Wide-field fundus photograph of an infant: 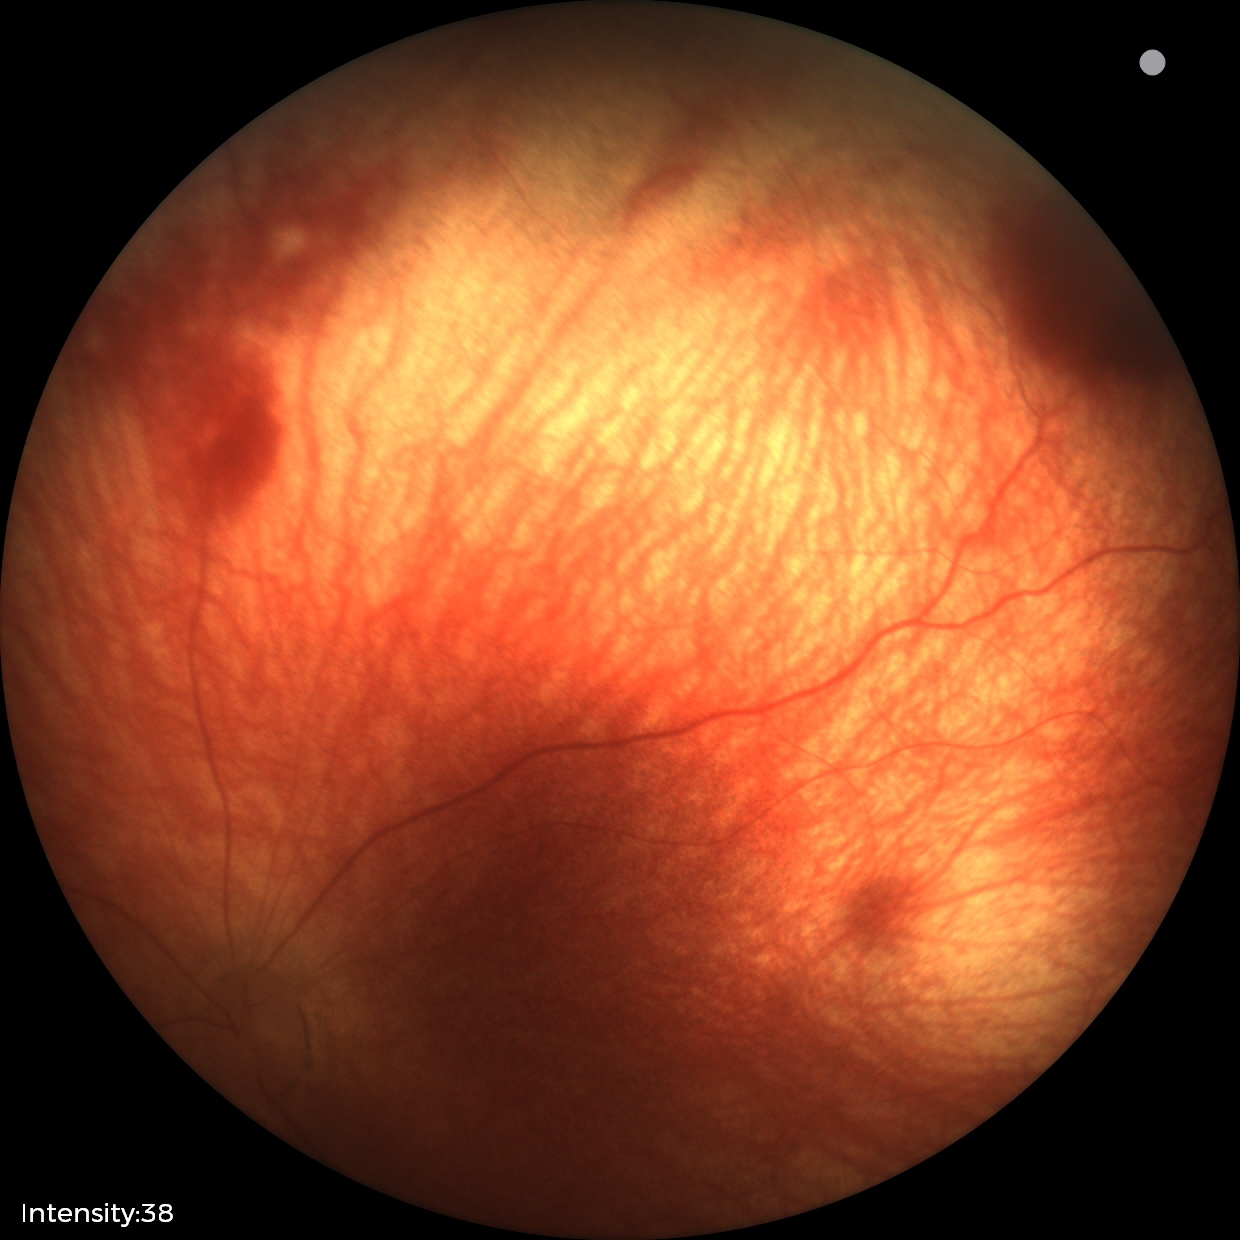

Diagnosis from this screening exam: retinal hemorrhages.